30° field of view · captured on a Topcon TRC-NW400 fundus camera · fundus photo · woman patient · central corneal thickness: 519 µm · autorefraction: sphere +1.75 D, cylinder -1 D, axis 125° · intraocular pressure 18 mmHg (pneumatic tonometry)
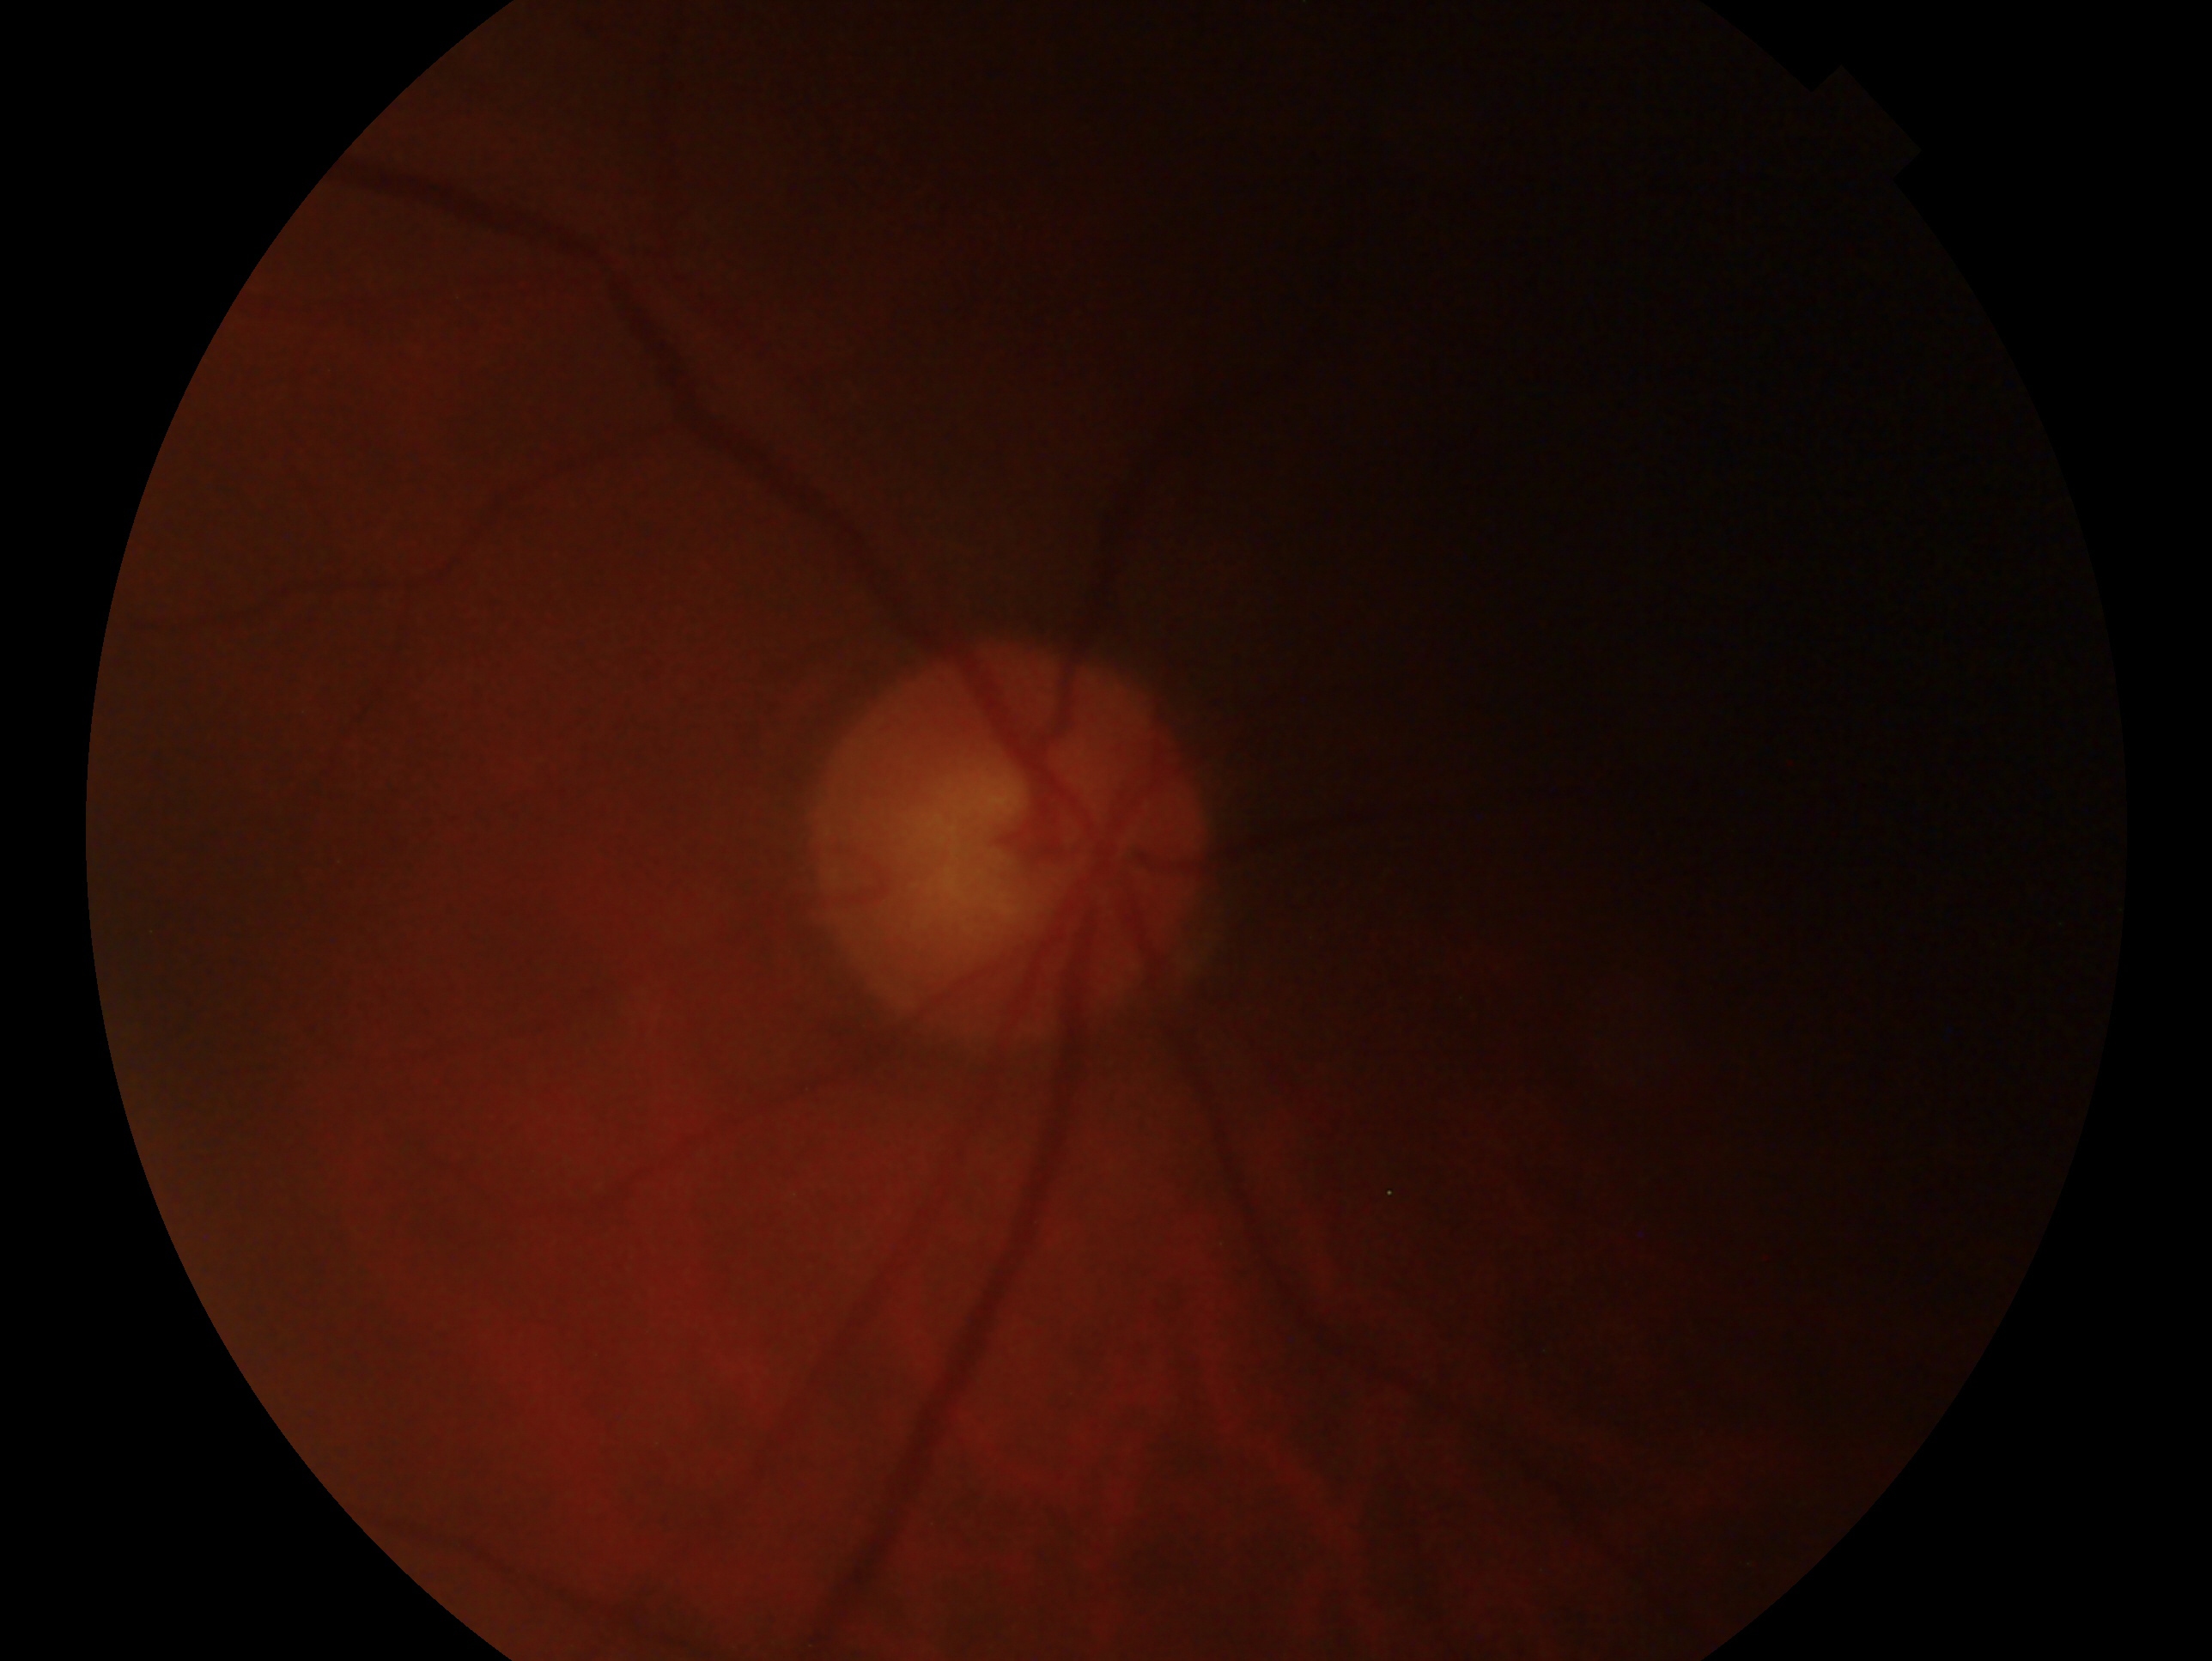 impression = no evidence of glaucoma; eye = OD.